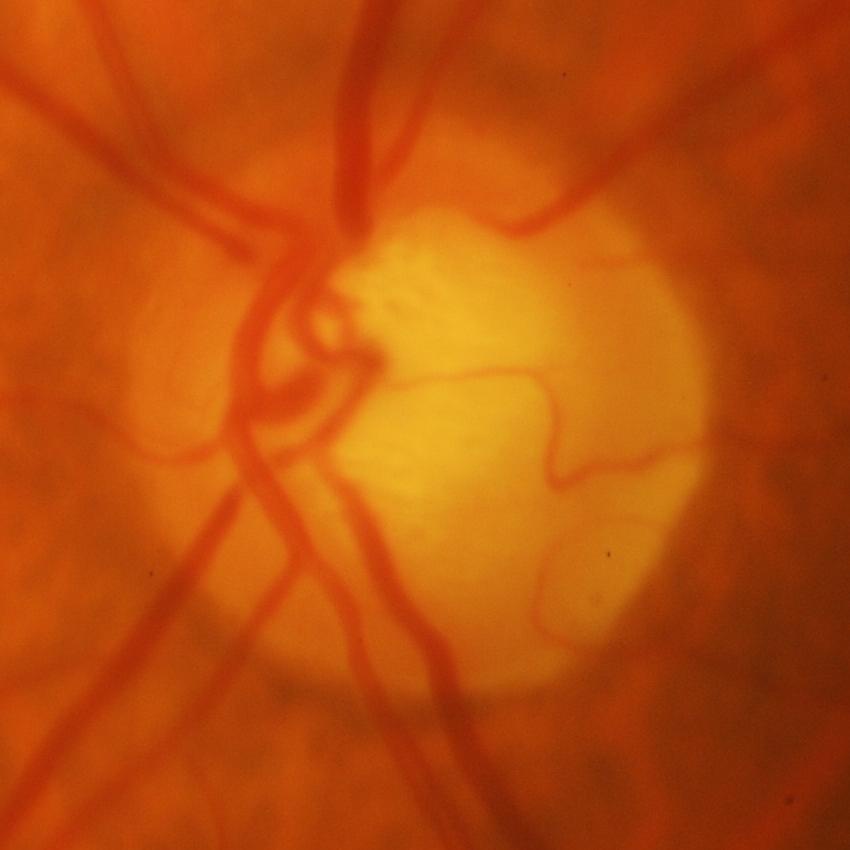
Glaucoma is present. Optic nerve head photograph demonstrating evidence of glaucoma.